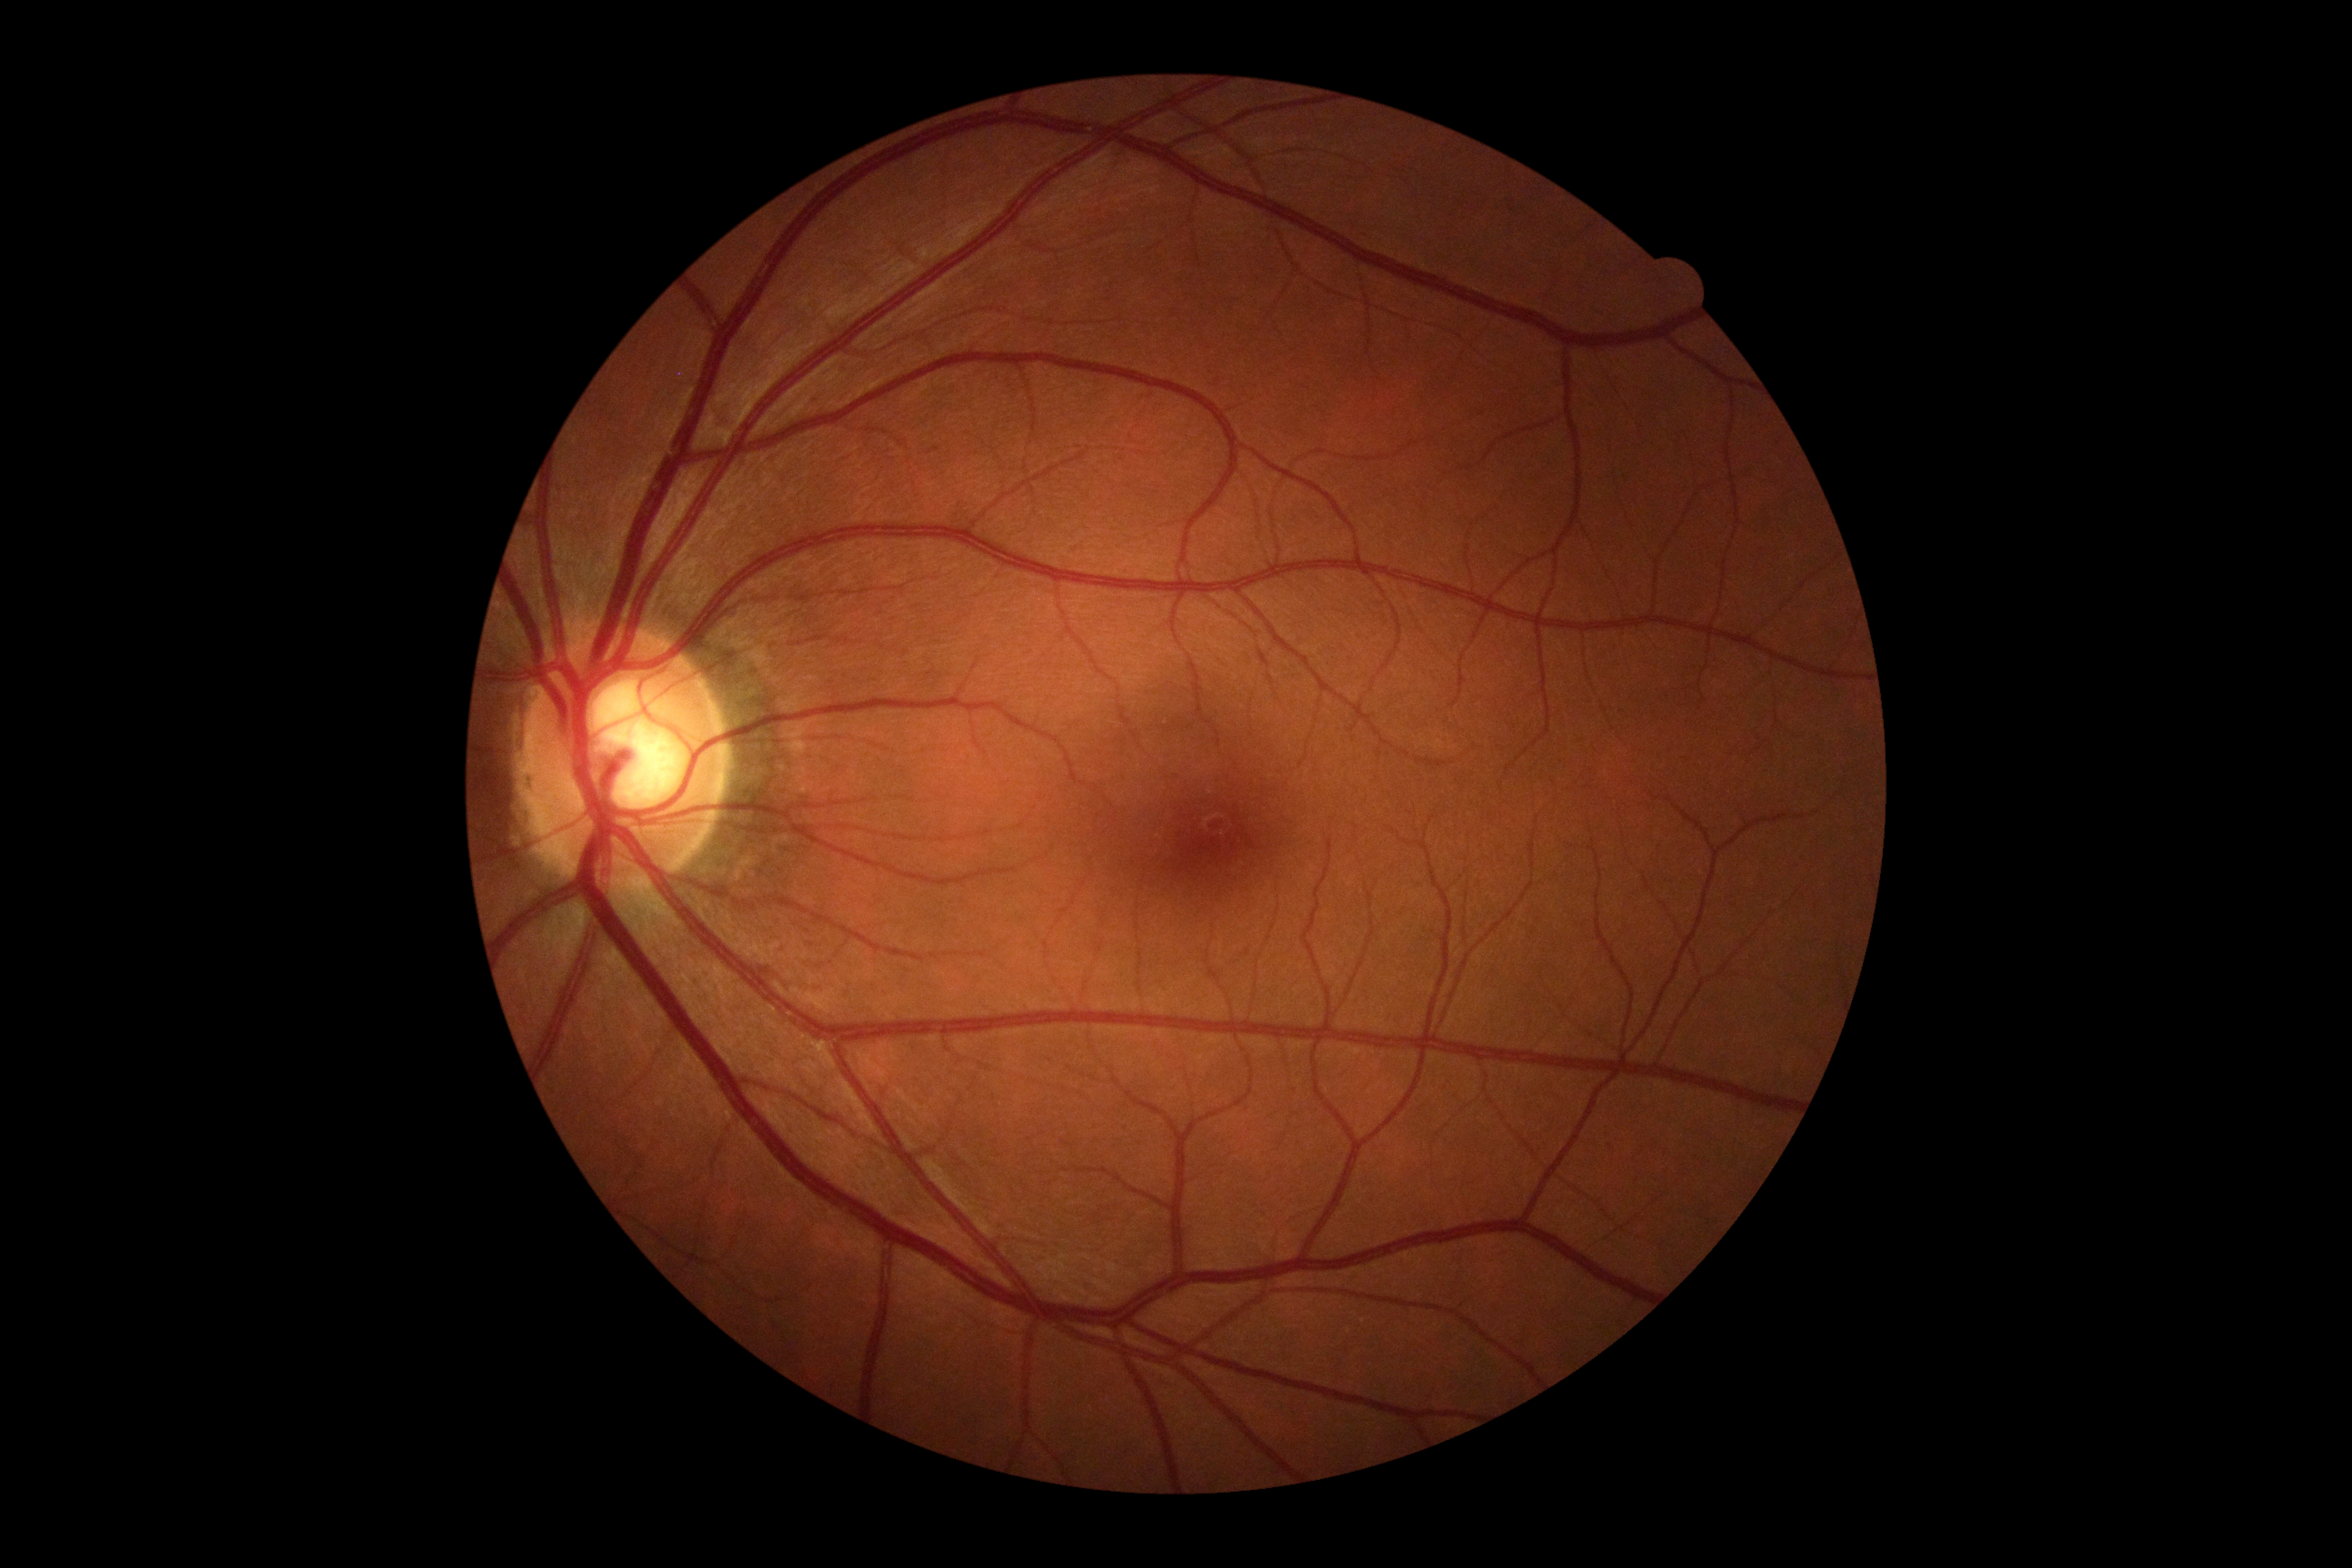
* DR stage — no apparent retinopathy (grade 0)
* DR impression — no apparent DR